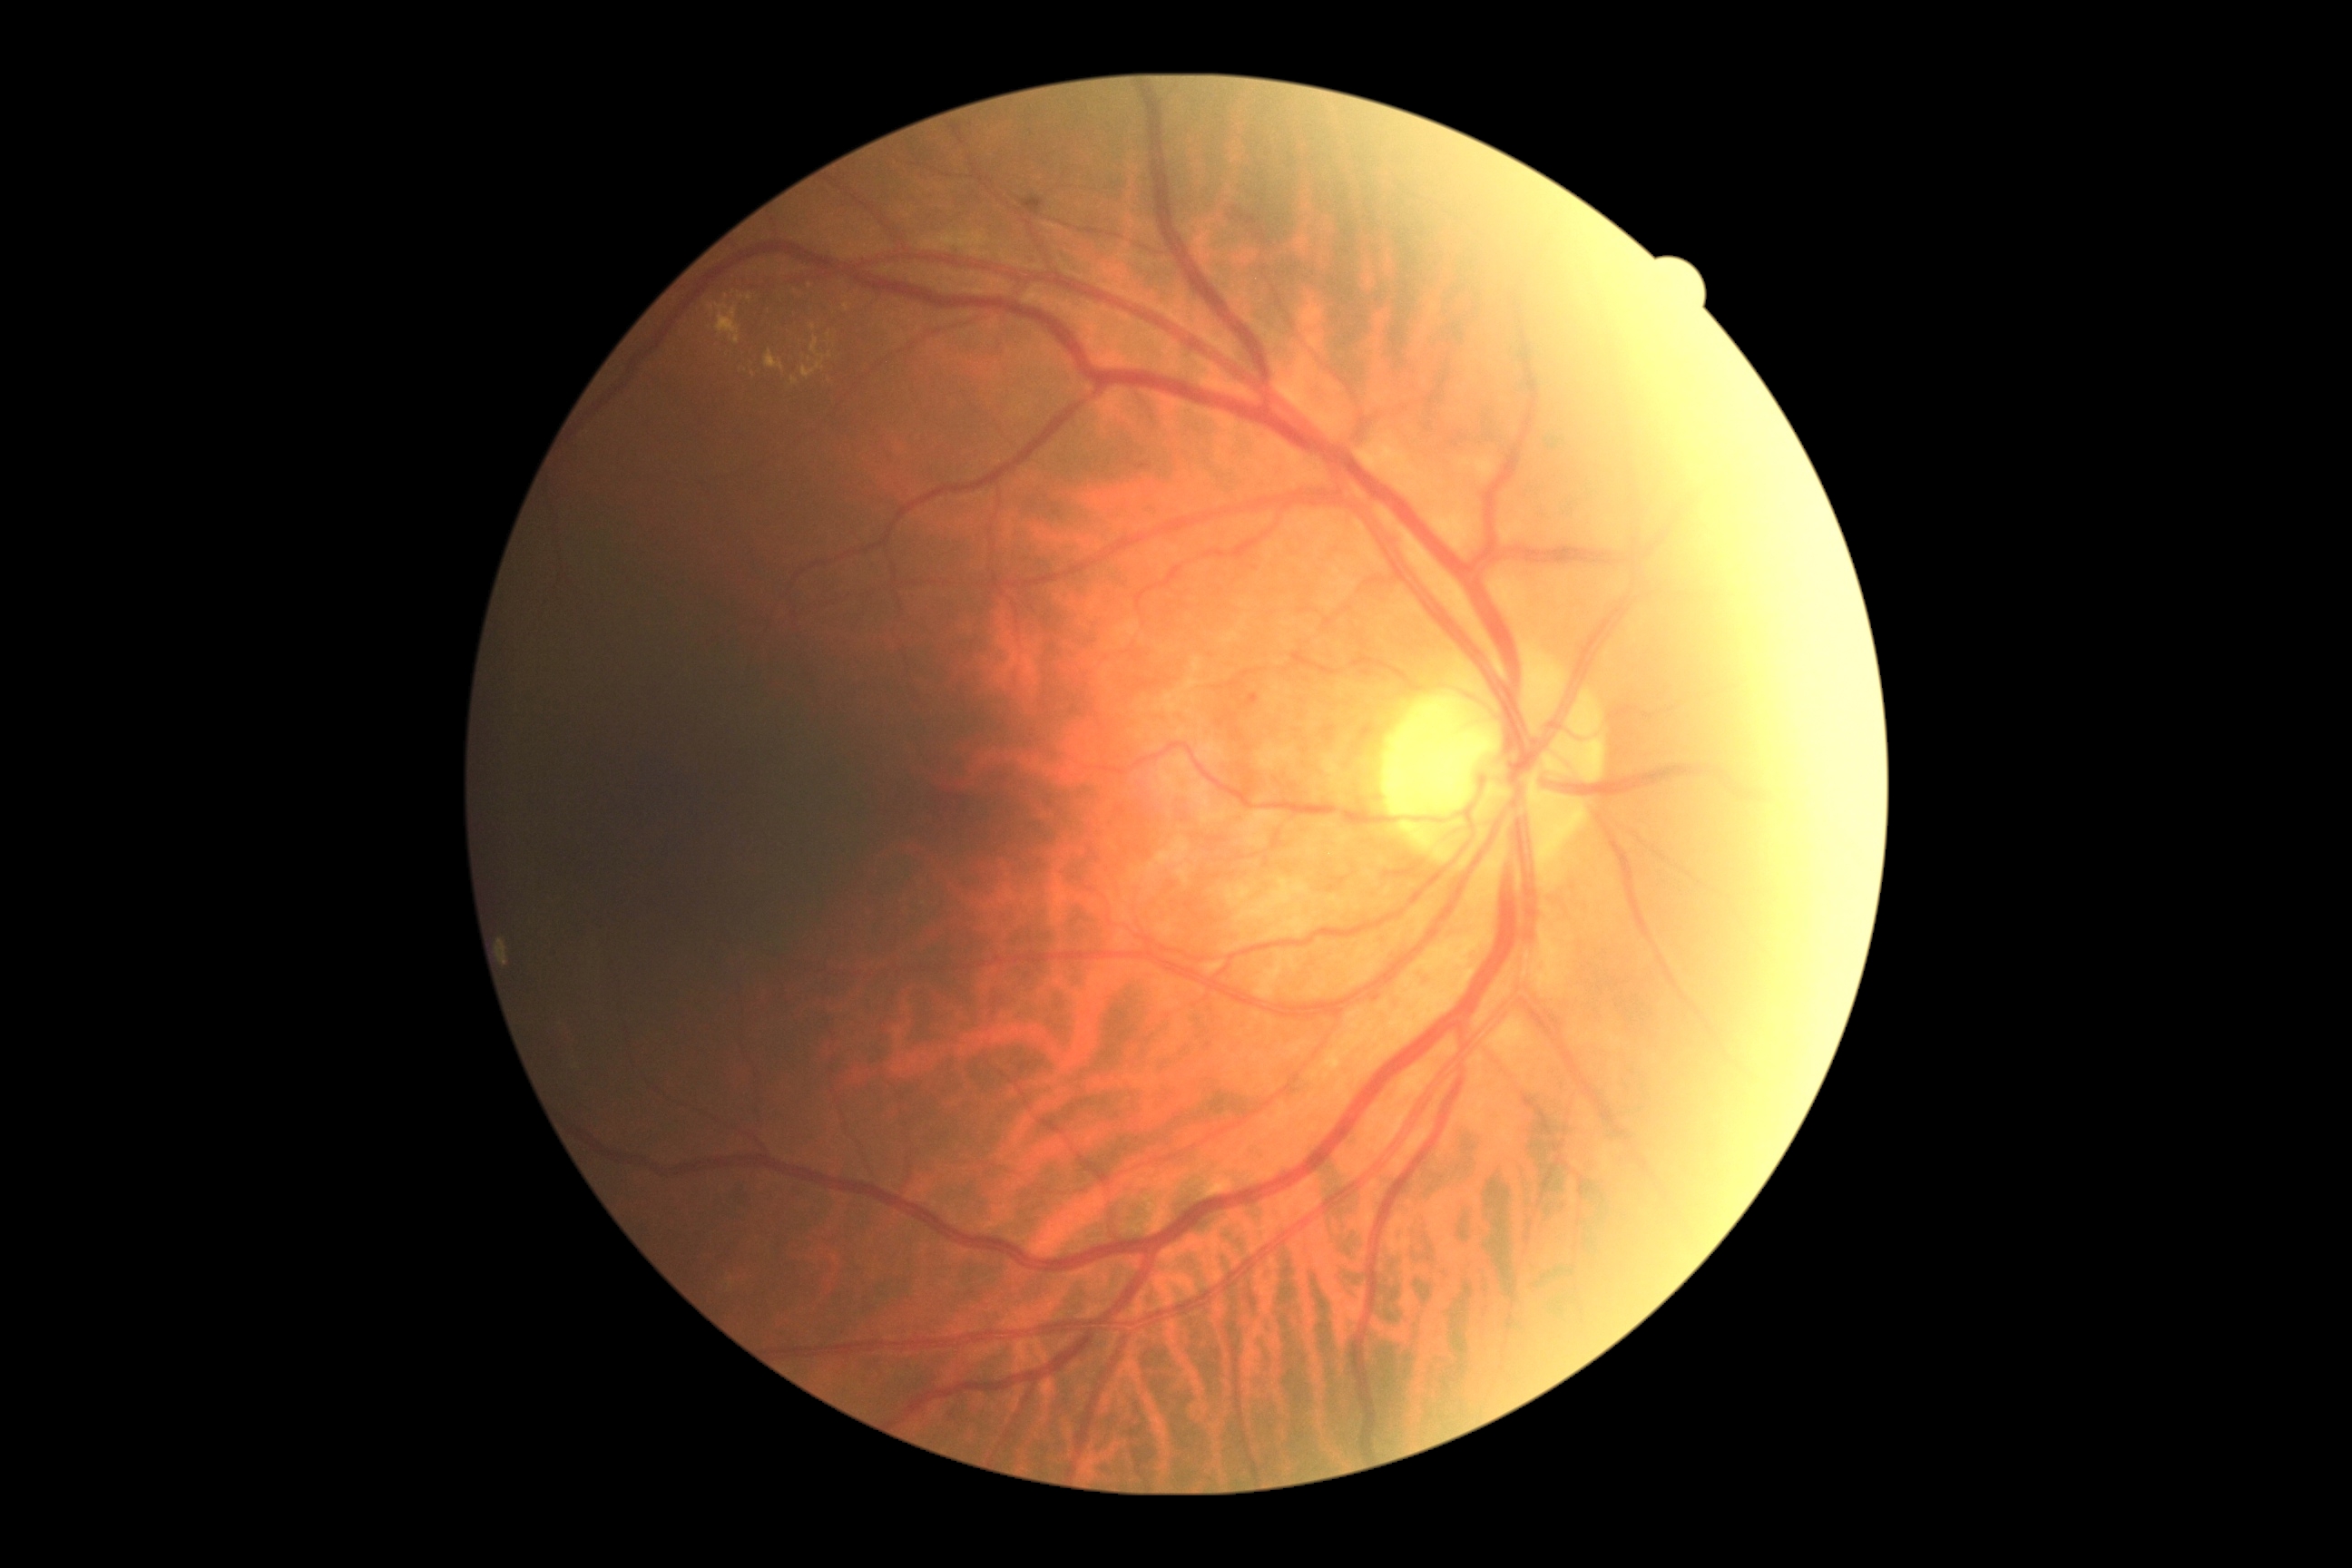

Findings:
* DR — 2/4
* DR class — non-proliferative diabetic retinopathy